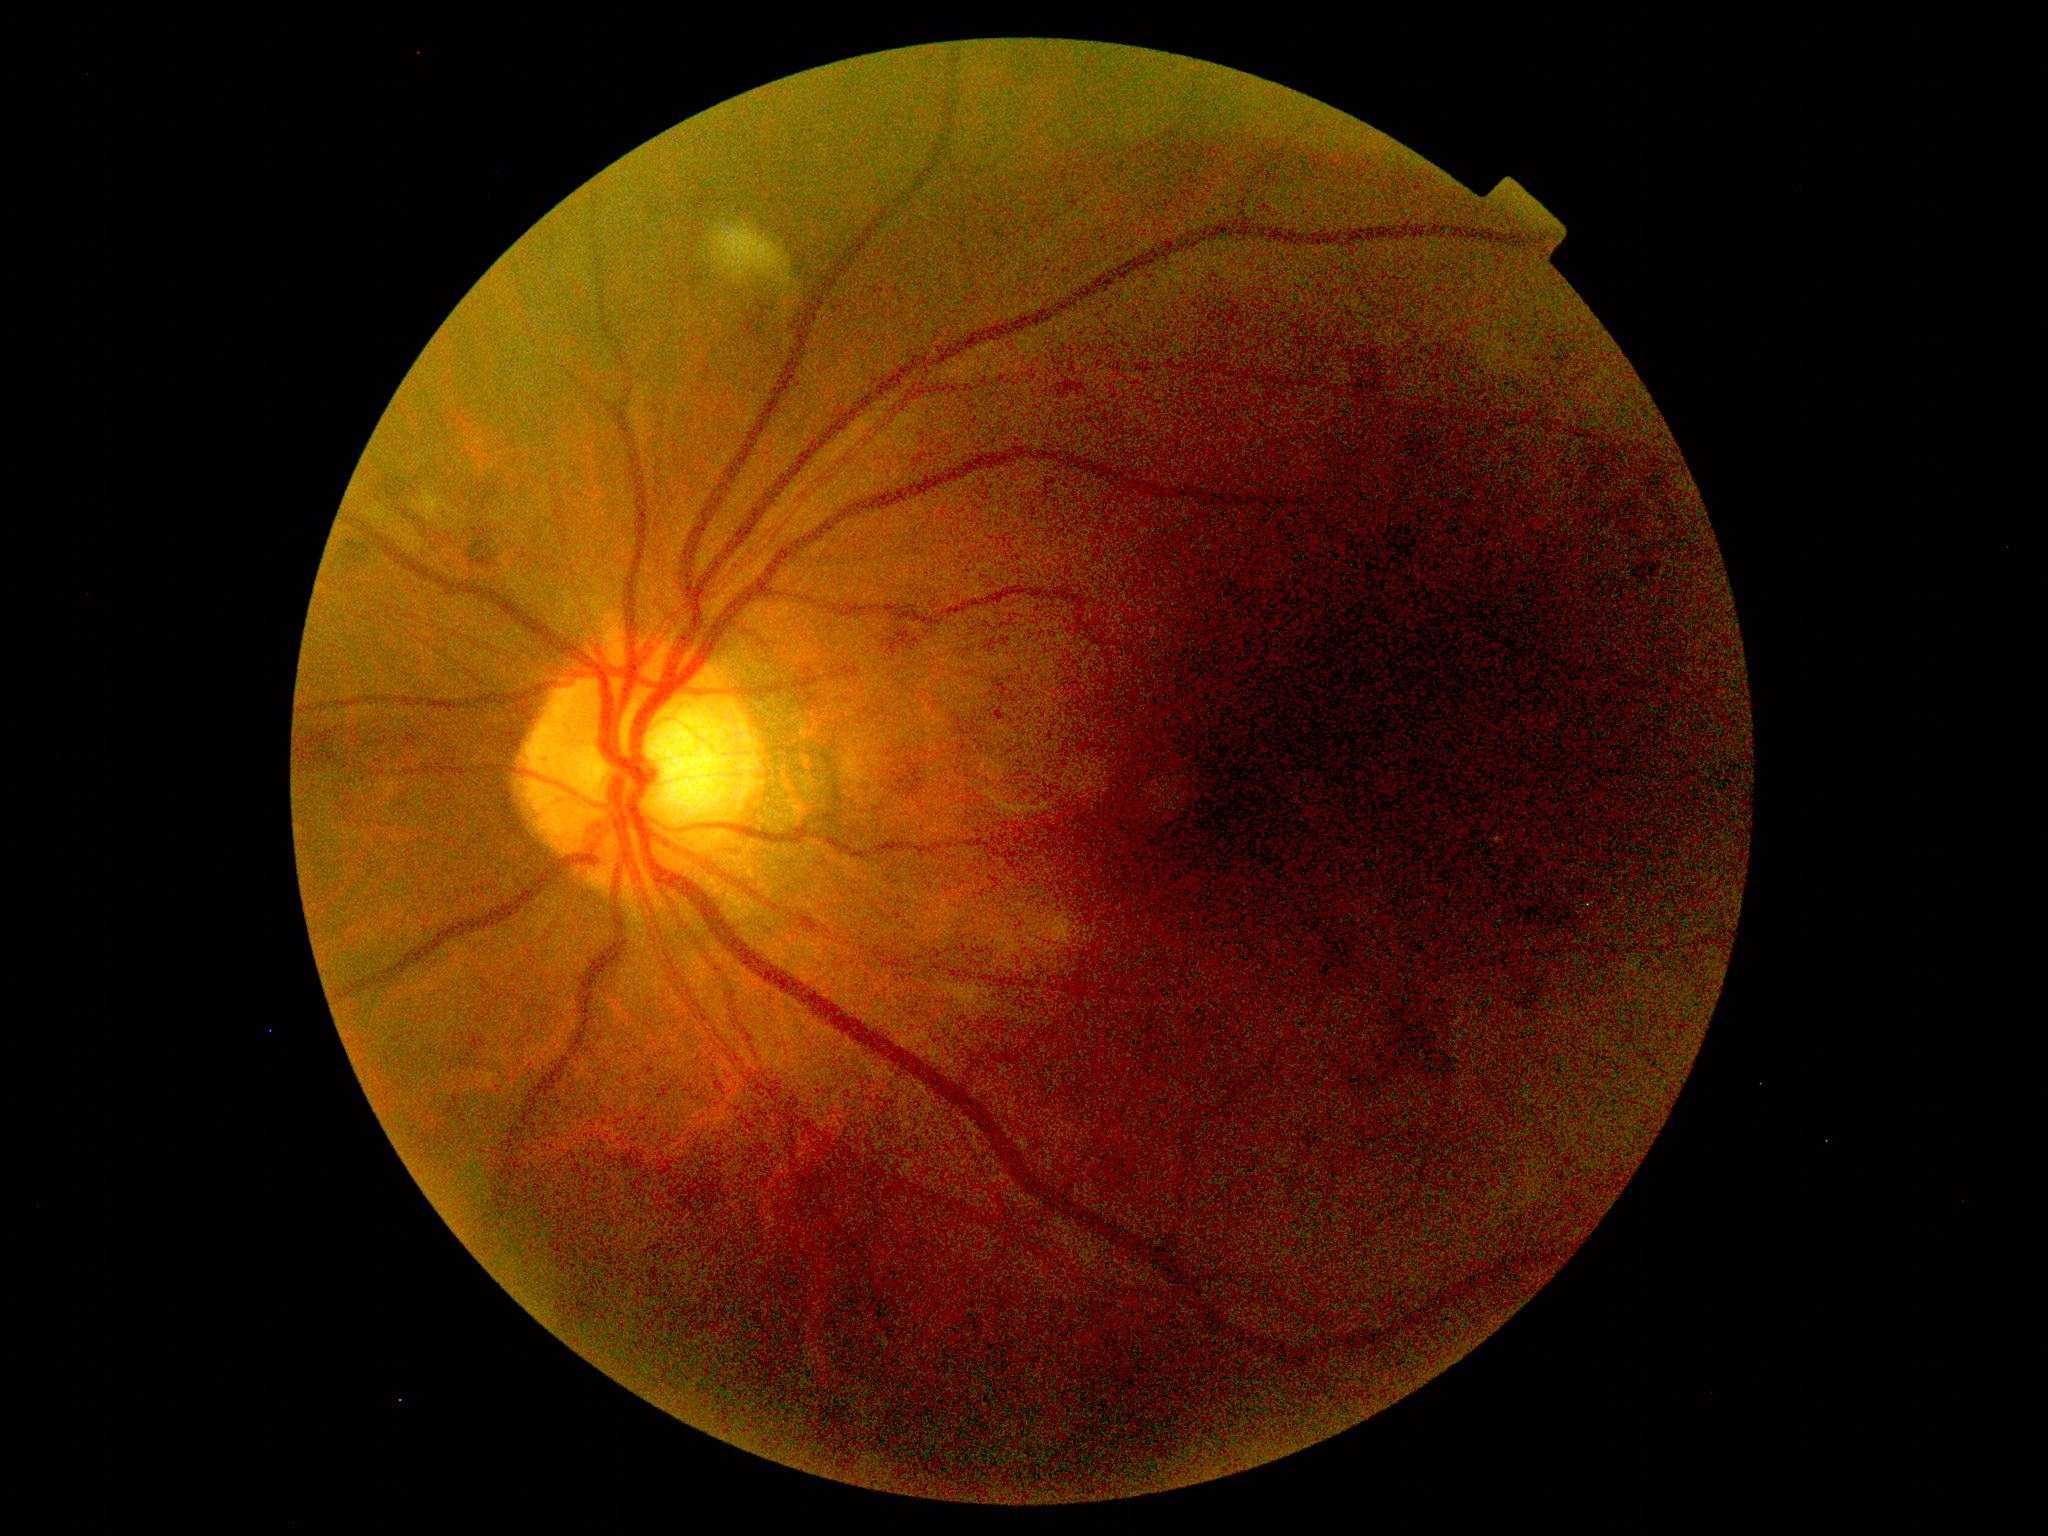
diabetic retinopathy severity=grade 2 (moderate NPDR).